Camera: NIDEK AFC-230. DR severity per modified Davis staging. Nonmydriatic fundus photograph:
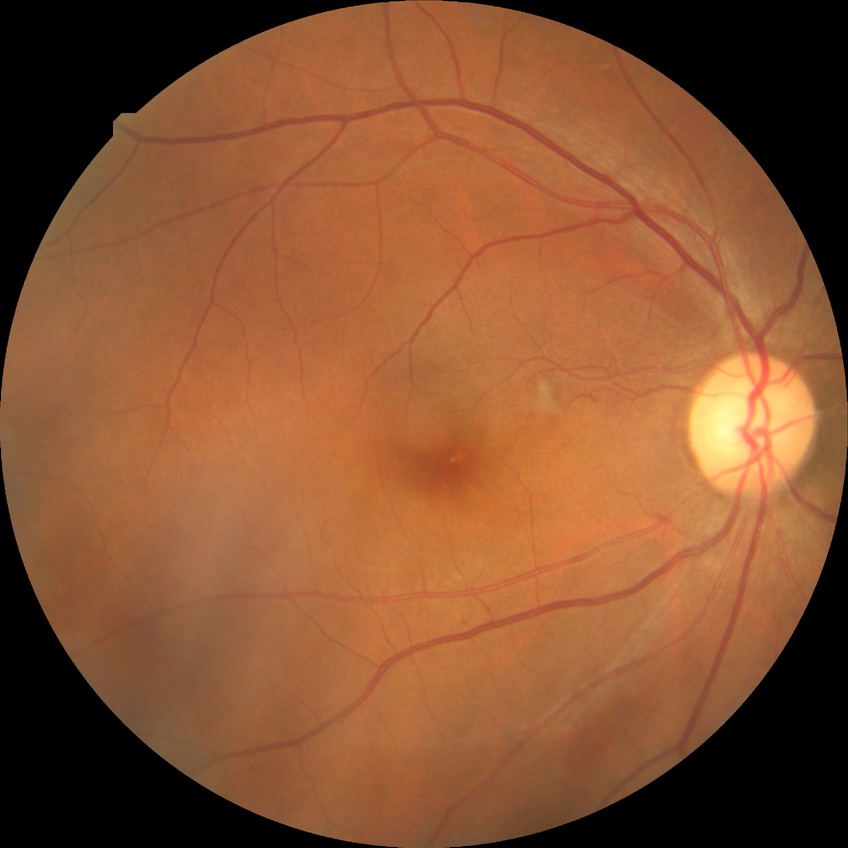 Davis DR grade: PPDR.